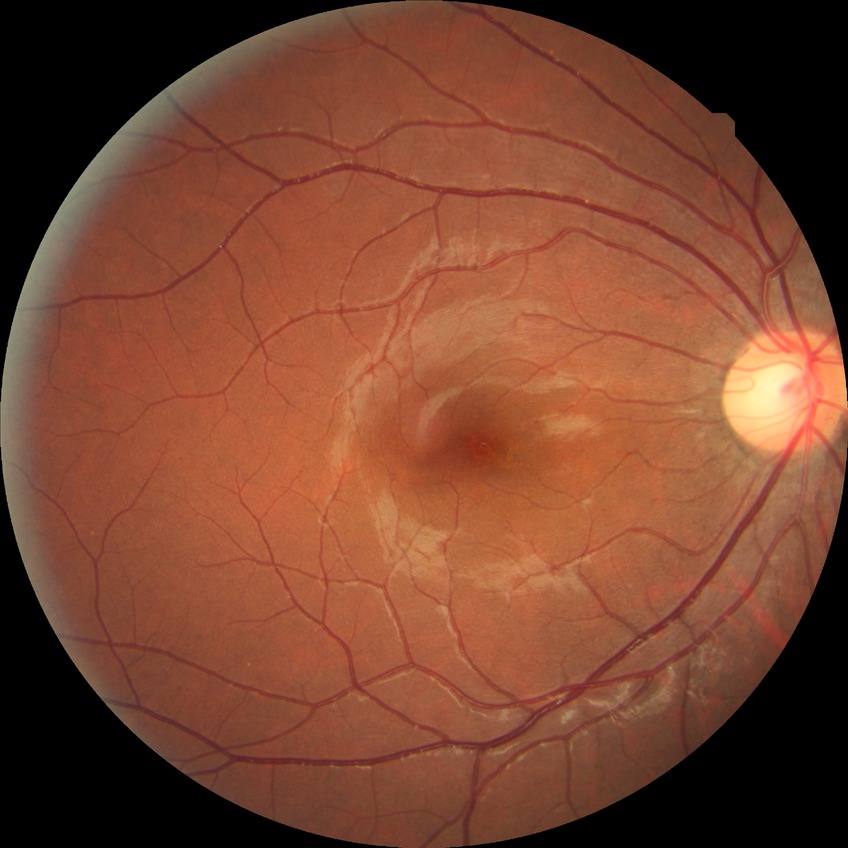

{"davis_grade": "NDR (no diabetic retinopathy)"}